CFP · acquired with a Remidio smartphone fundus camera · image size 1659x2212
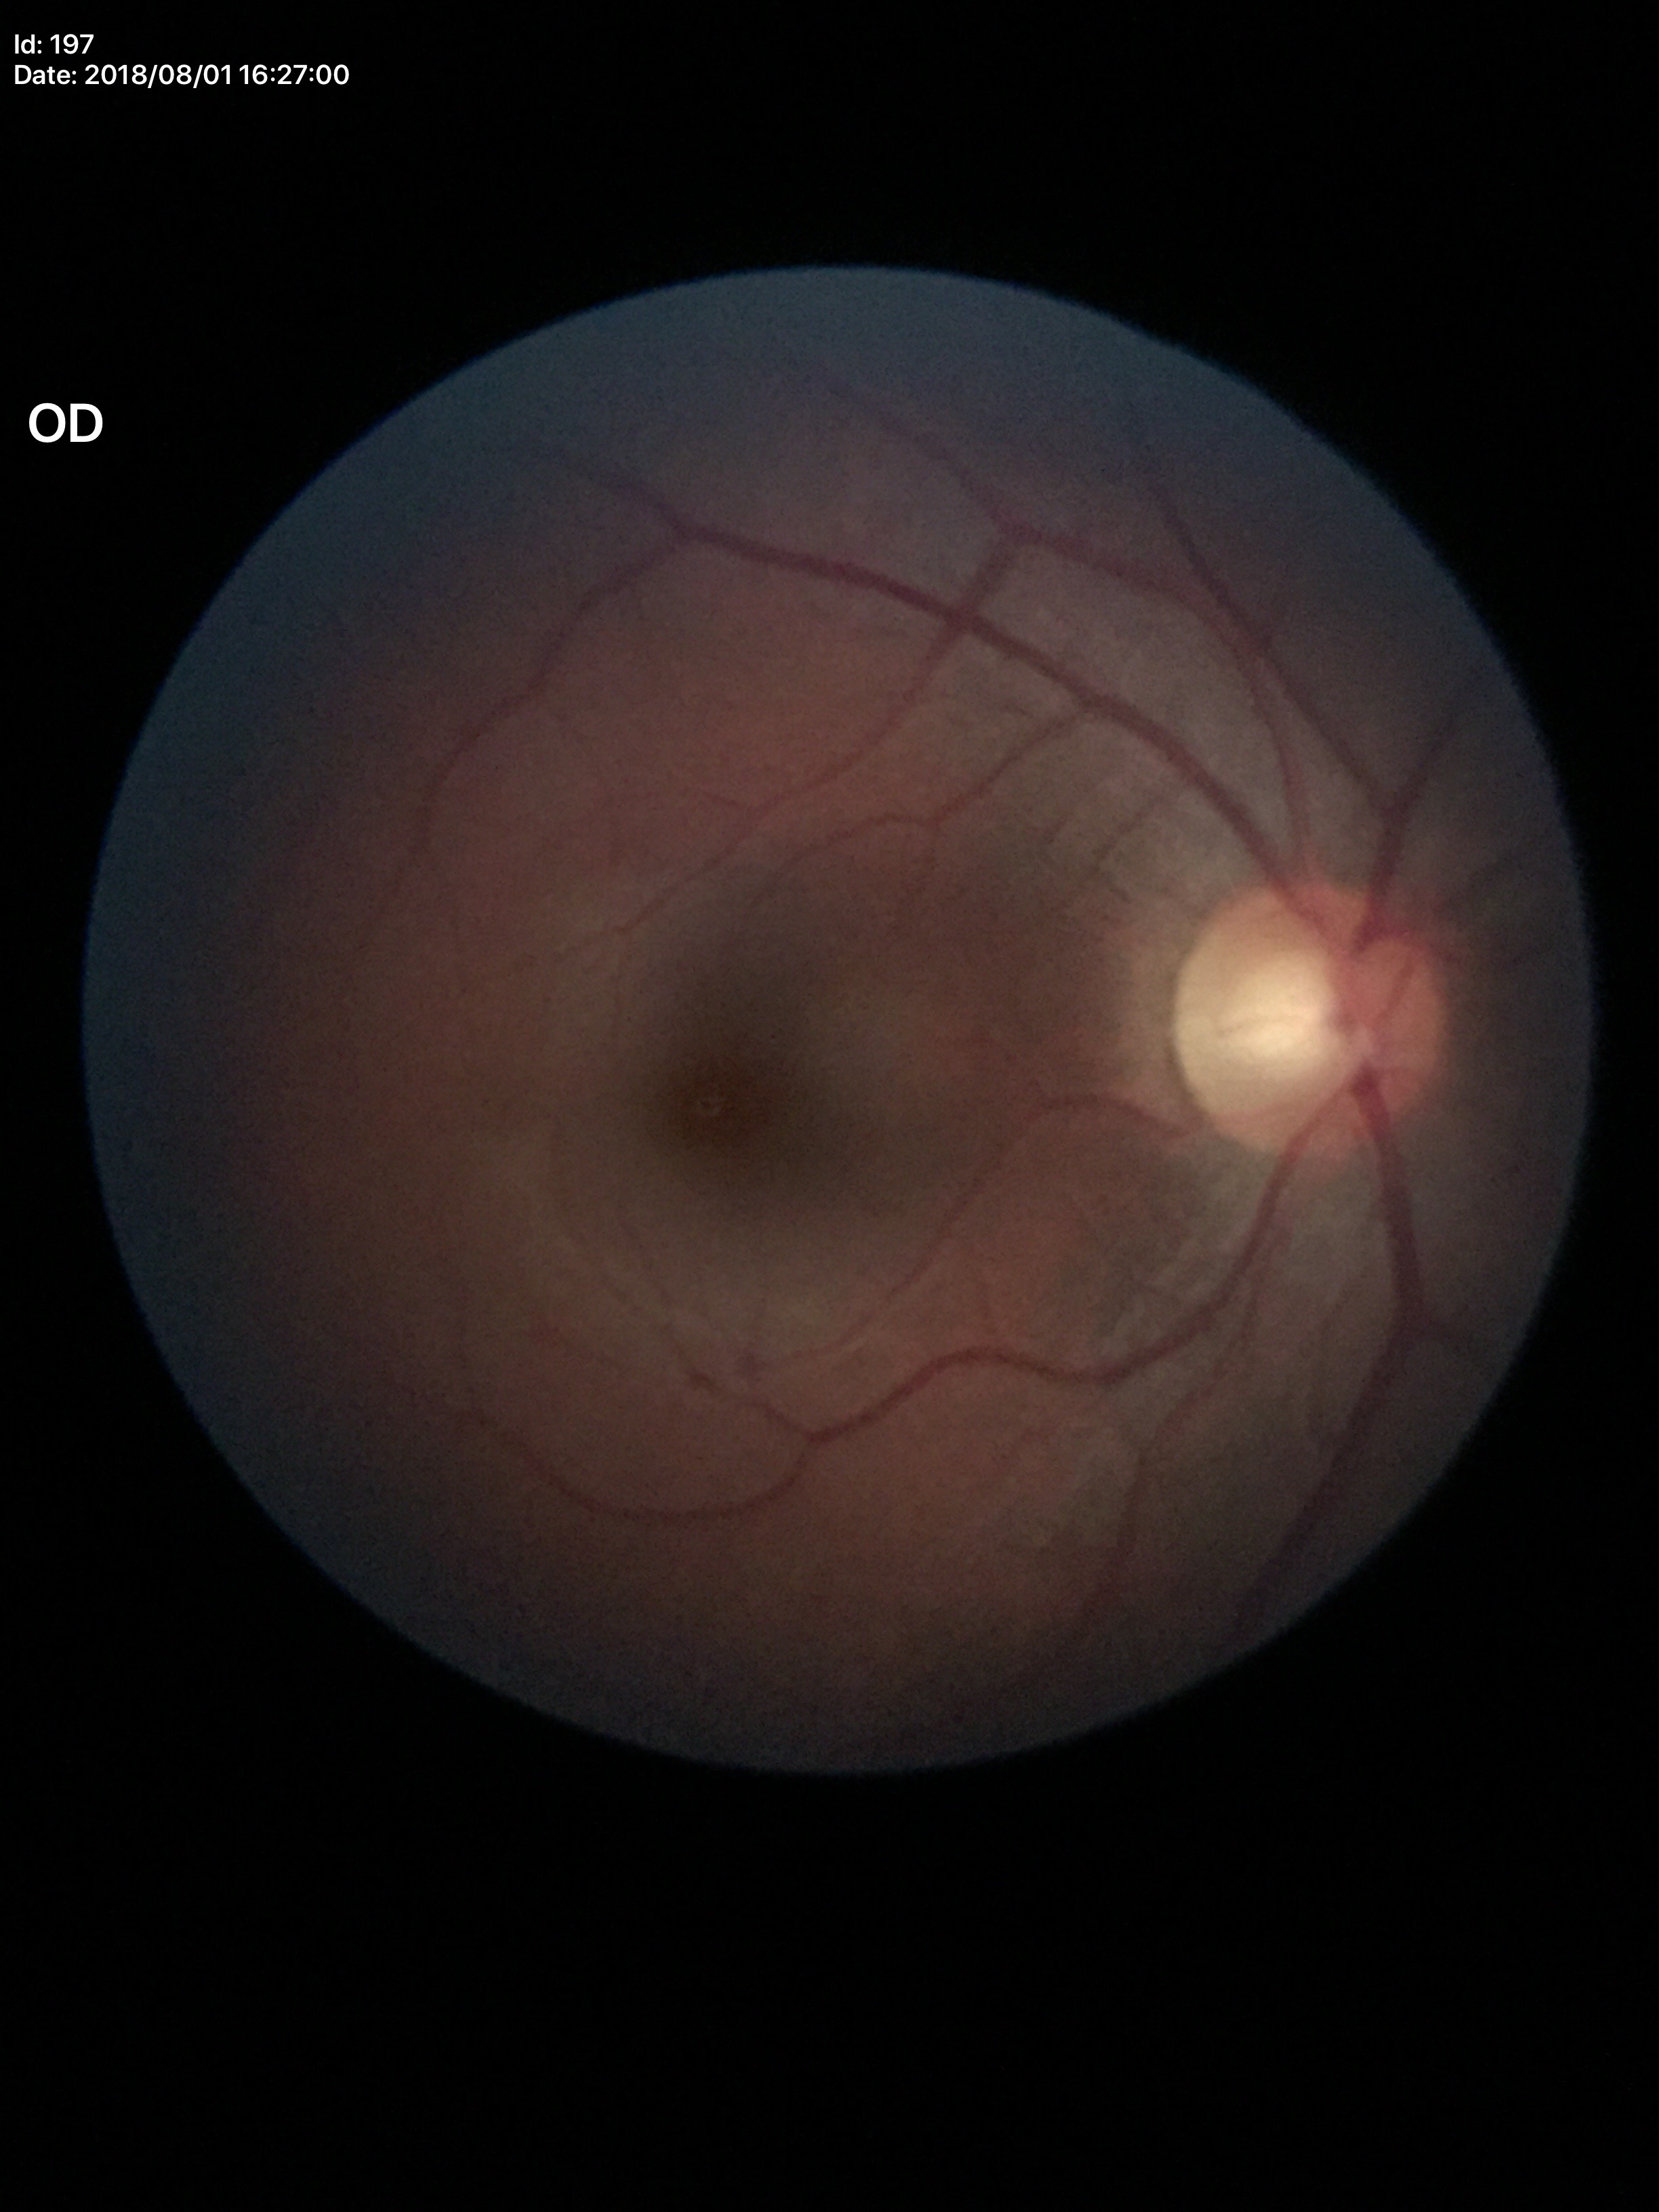

{
  "glaucoma_decision": "not suspect (1 of 5 graders flagged glaucoma suspect)",
  "acdr": "0.35",
  "vcdr": "0.54",
  "hcdr": "0.63"
}